DR severity per modified Davis staging · 45-degree field of view:
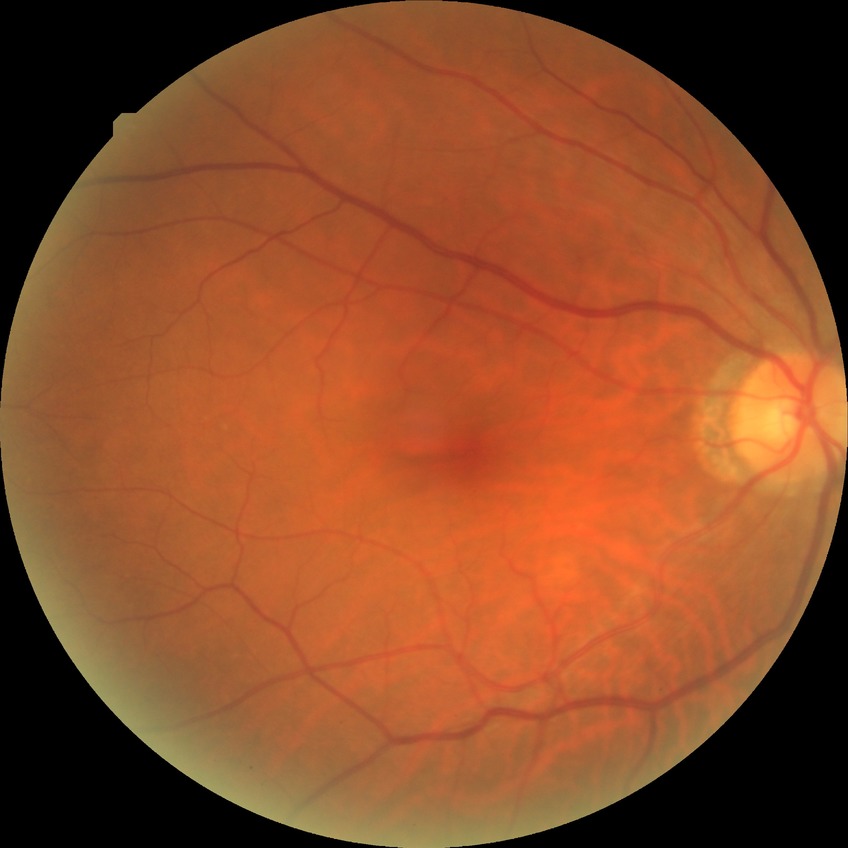

Diabetic retinopathy stage: no diabetic retinopathy.